2352 by 1568 pixels · FOV: 45 degrees · retinal fundus photograph — 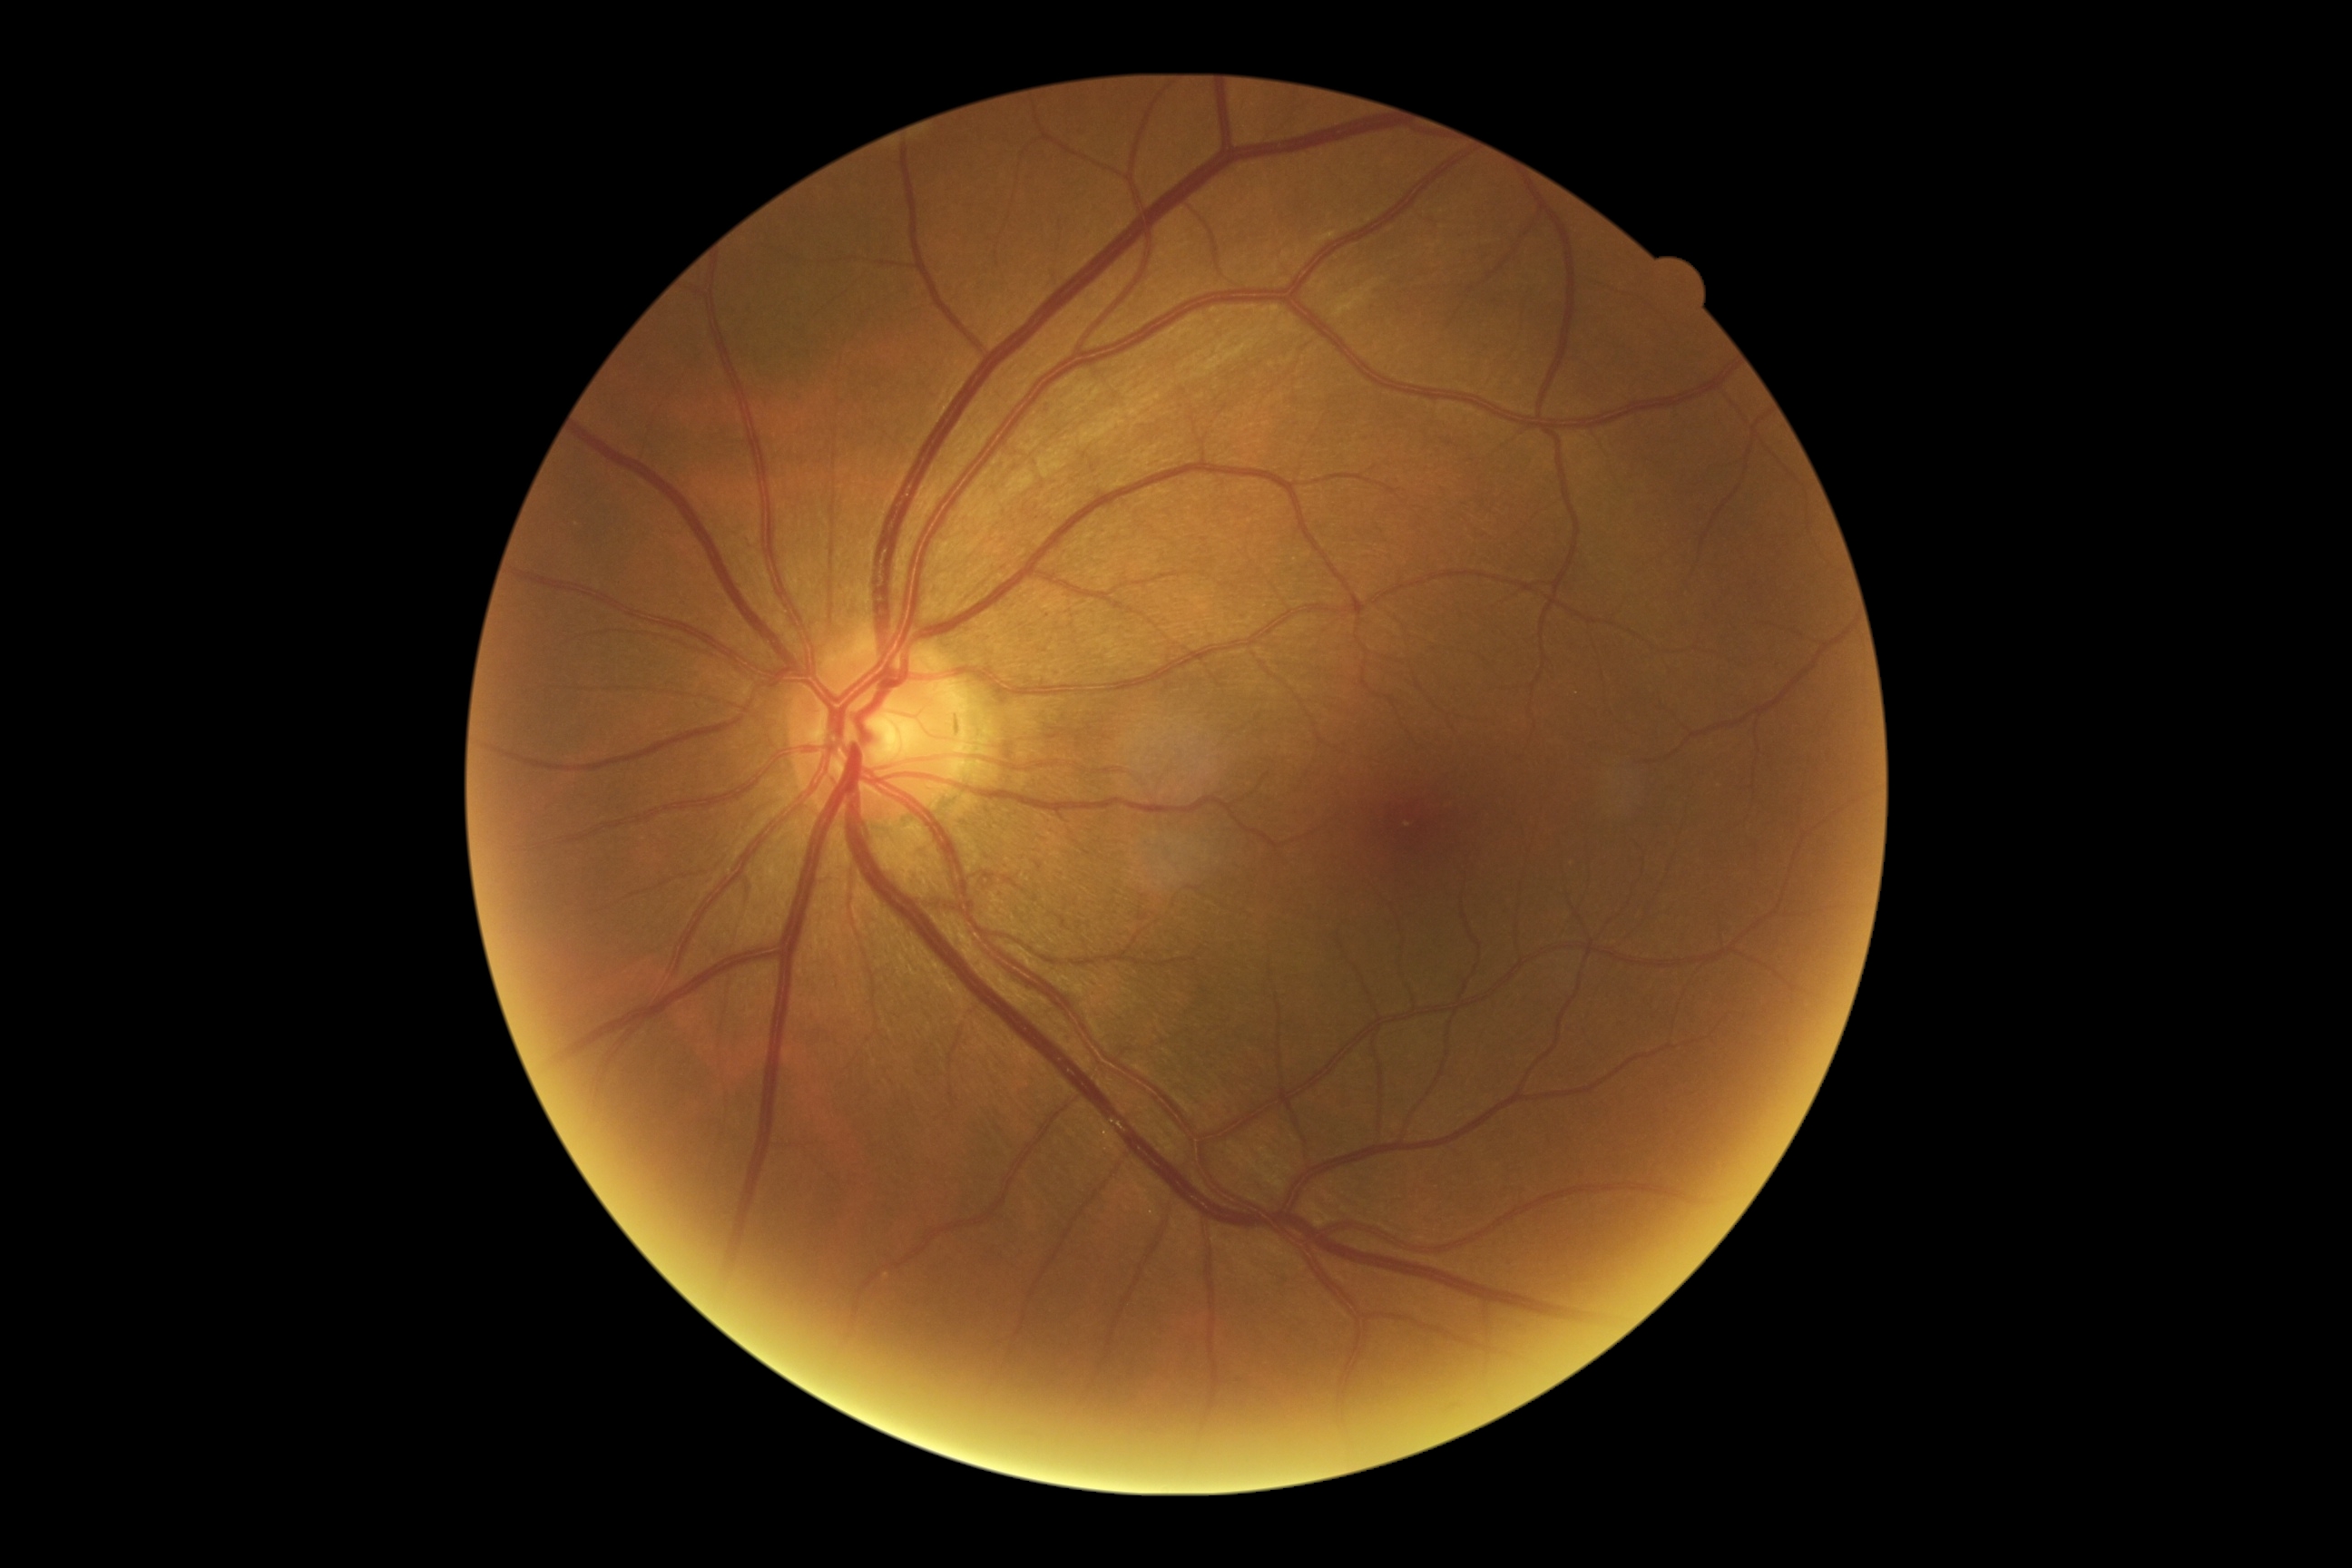

Diabetic retinopathy (DR): 0/4. No signs of diabetic retinopathy.